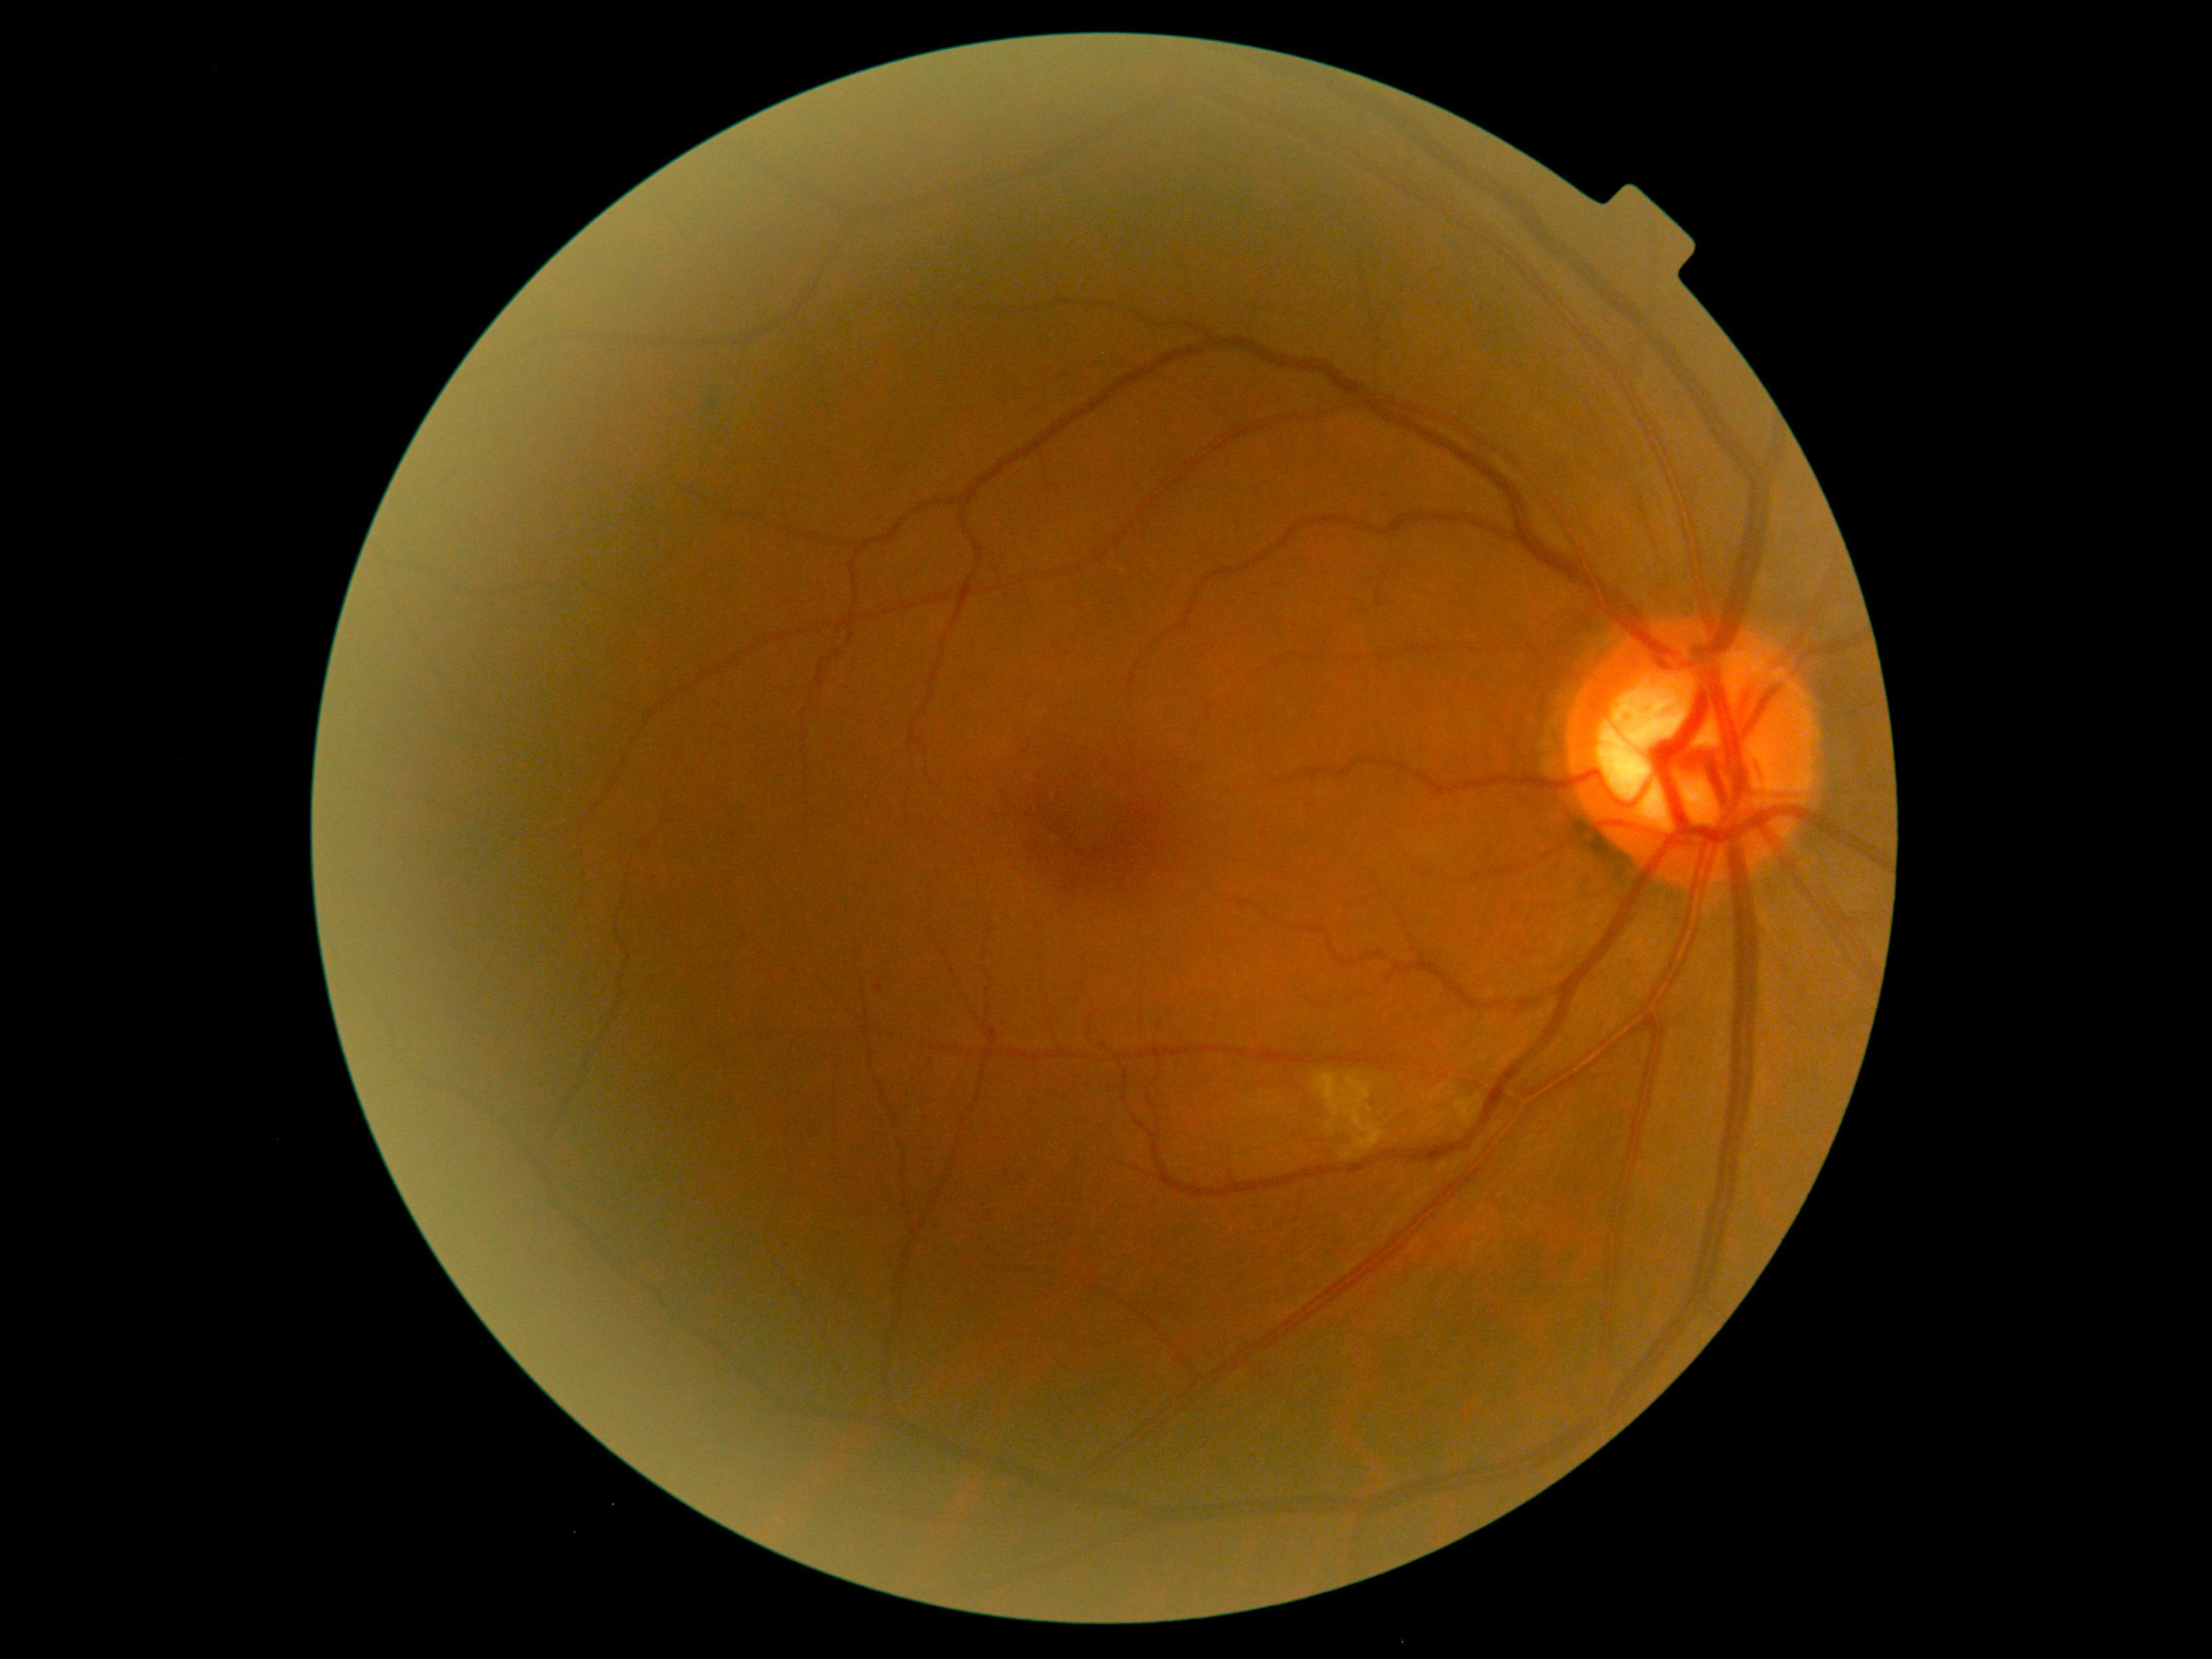 Diabetic retinopathy (DR) is 2.